CFP
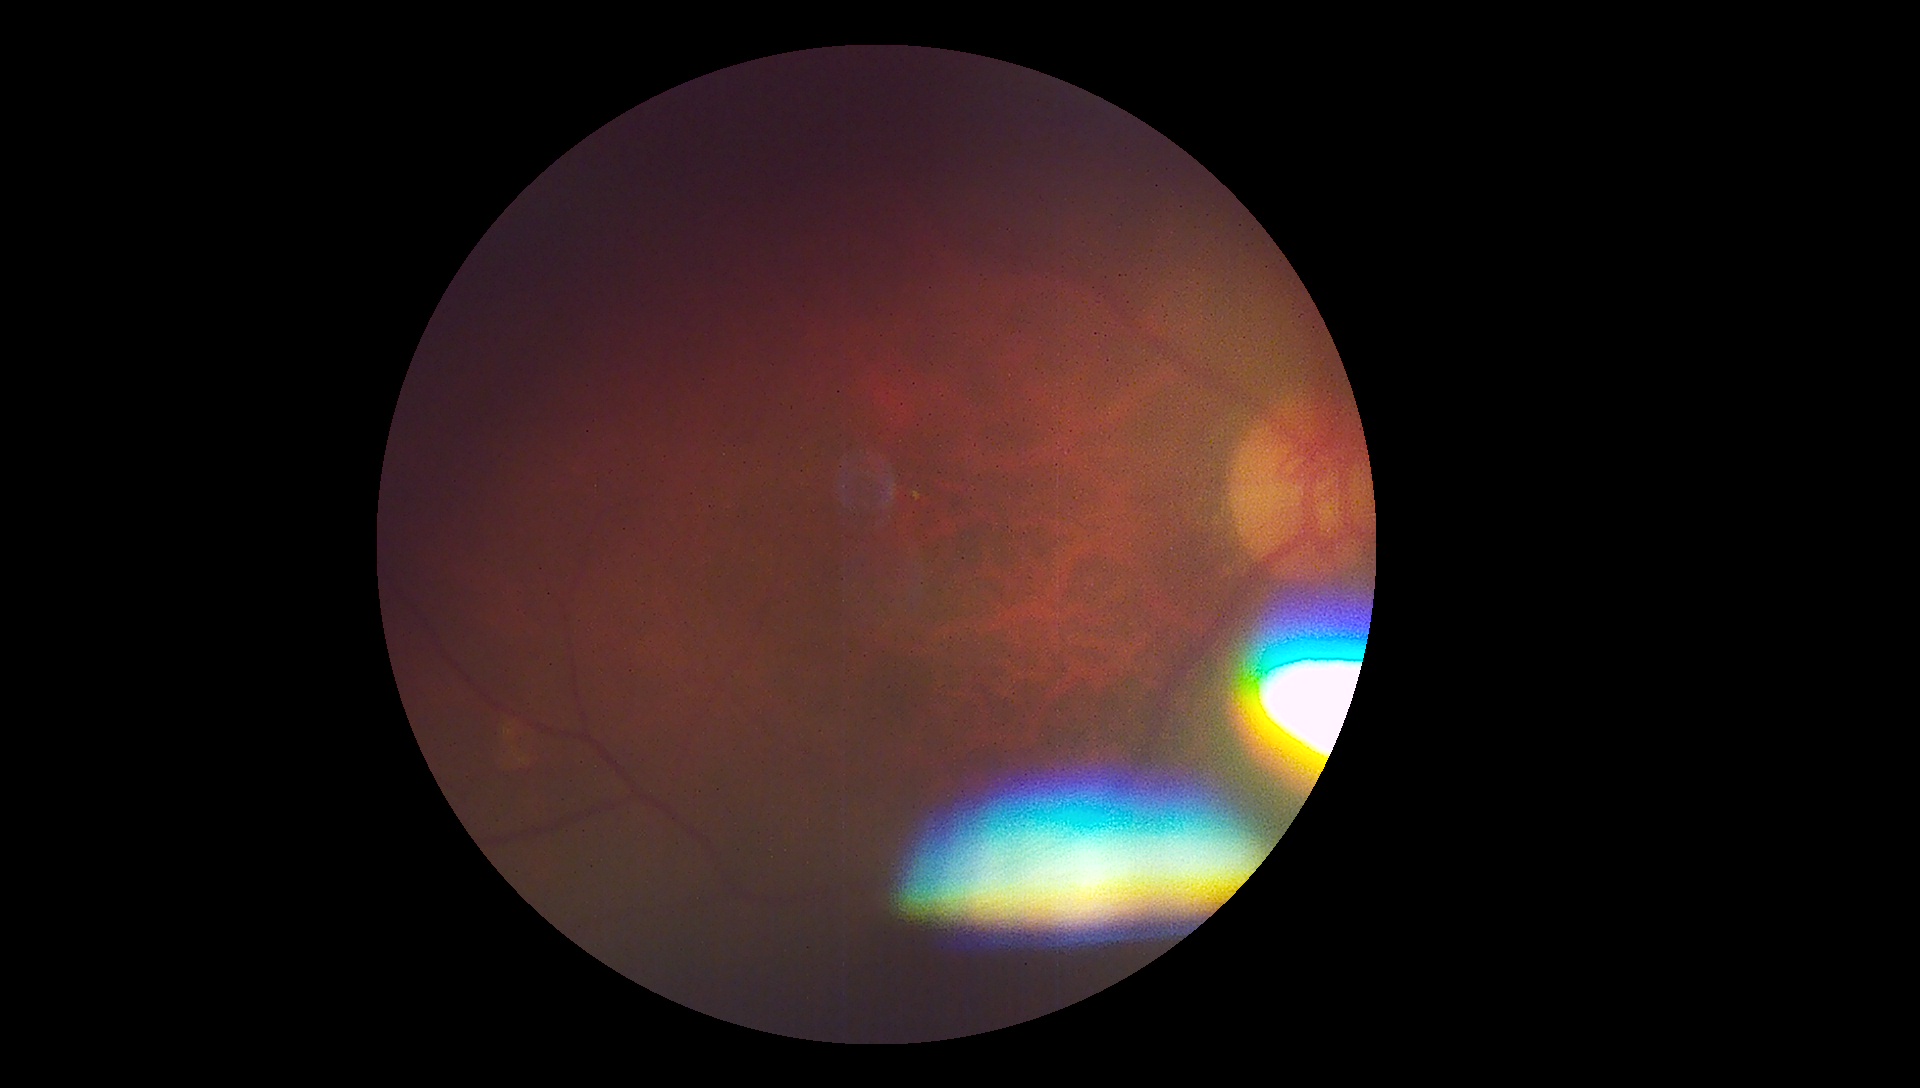 Findings:
– image quality — insufficient for DR assessment
– DR severity — ungradable